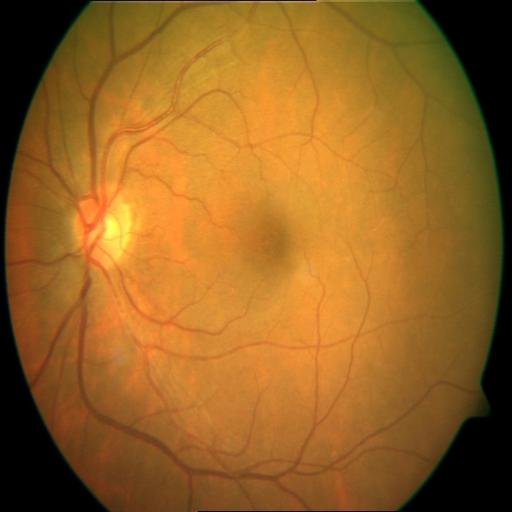
Findings:
- cystoid macular edema (CME)